45° field of view. Without pupil dilation — 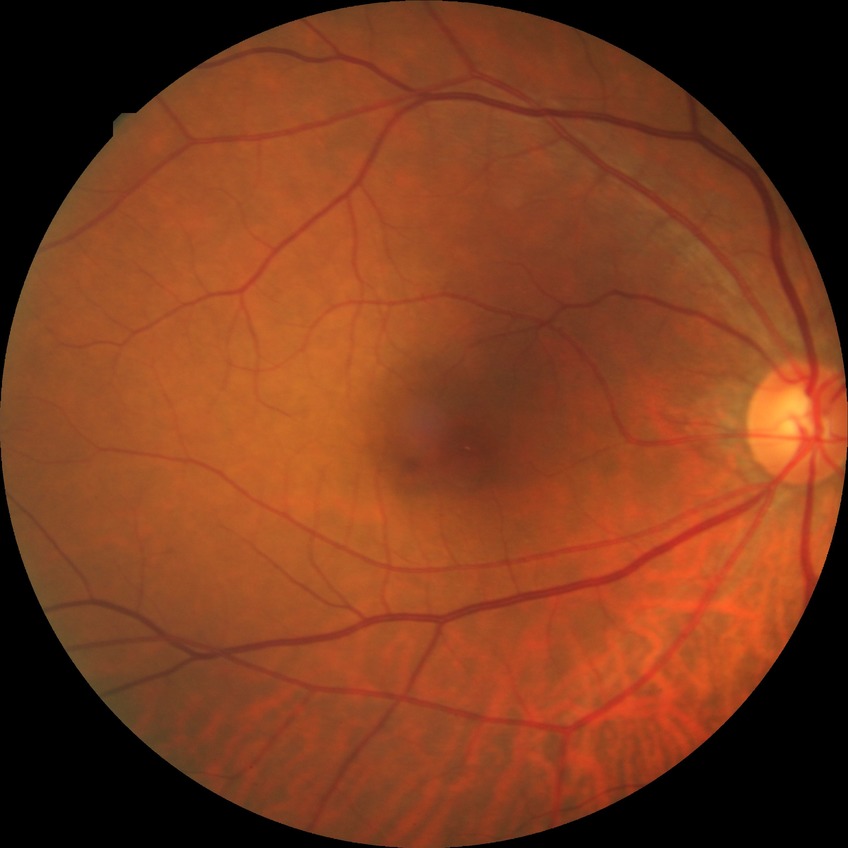 Diabetic retinopathy (DR): NDR (no diabetic retinopathy).